Fundus photo · 45° FOV:
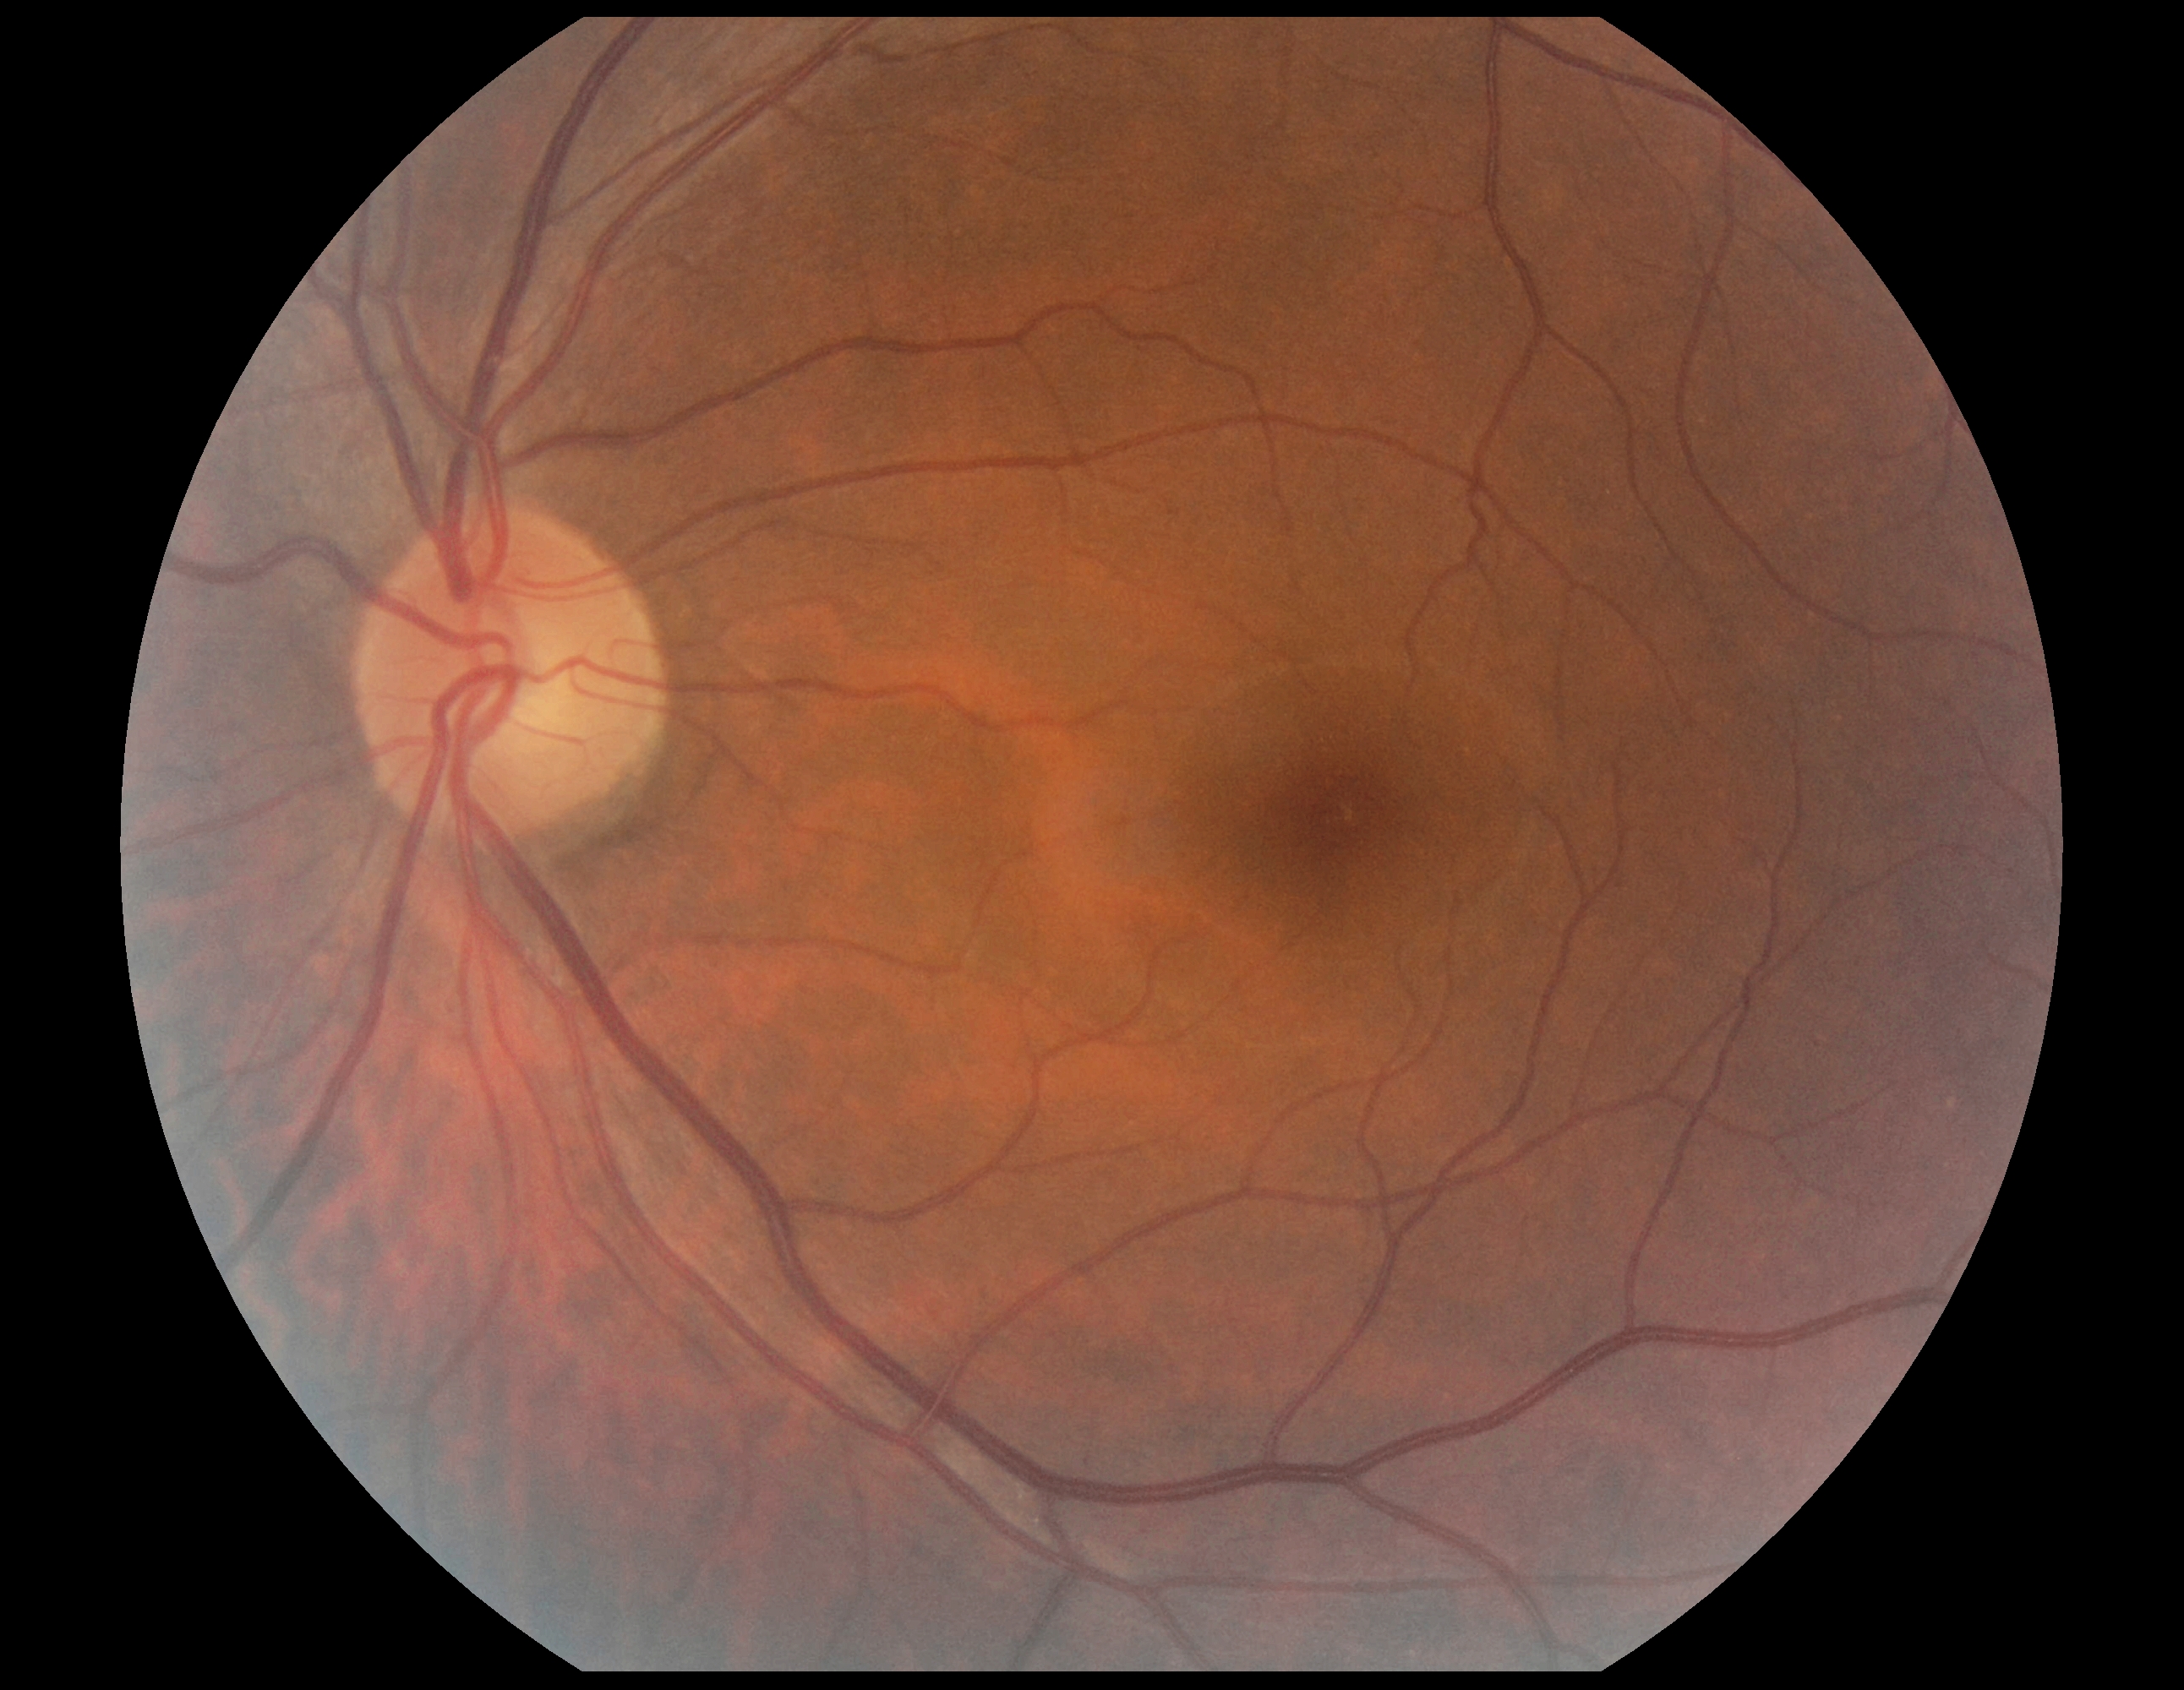

No diabetic retinal disease findings.
Diabetic retinopathy severity is 0/4.